Acquired with a NIDEK AFC-230. Posterior pole photograph — 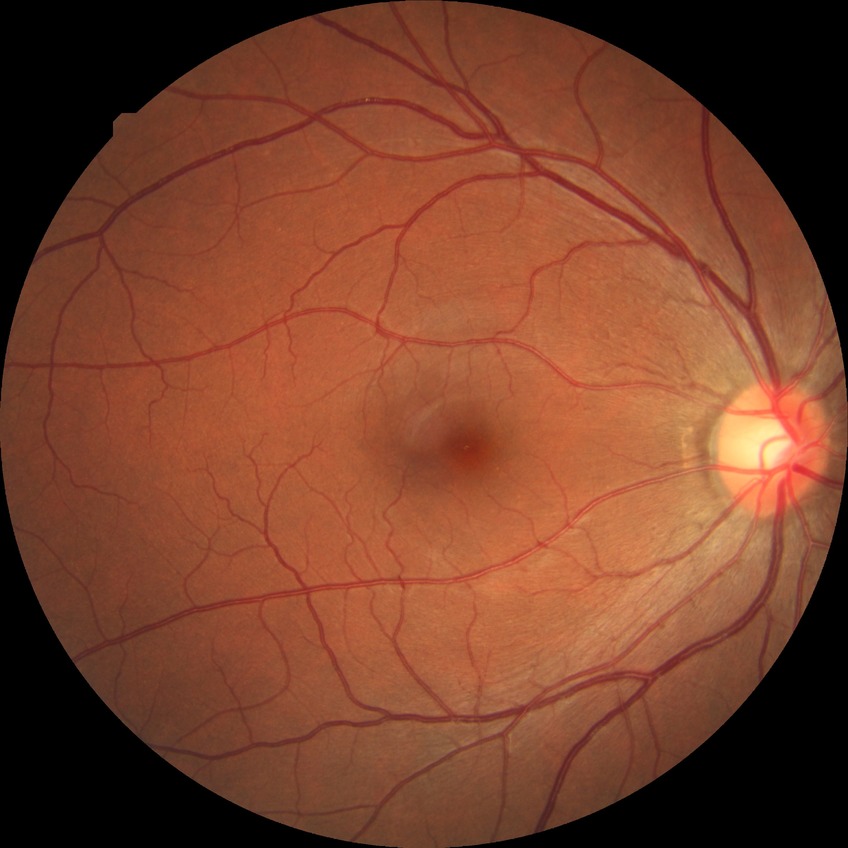
diabetic retinopathy (DR): no diabetic retinopathy (NDR).